Pediatric wide-field fundus photograph:
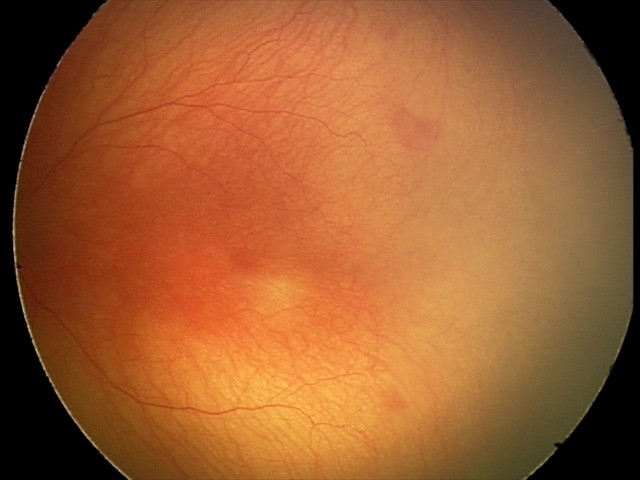 Impression: A-ROP (aggressive ROP) — rapidly progressive severe ROP with prominent plus disease, often without classic stage progression; plus disease — abnormal dilation and tortuosity of the posterior pole retinal vessels.